45-degree field of view:
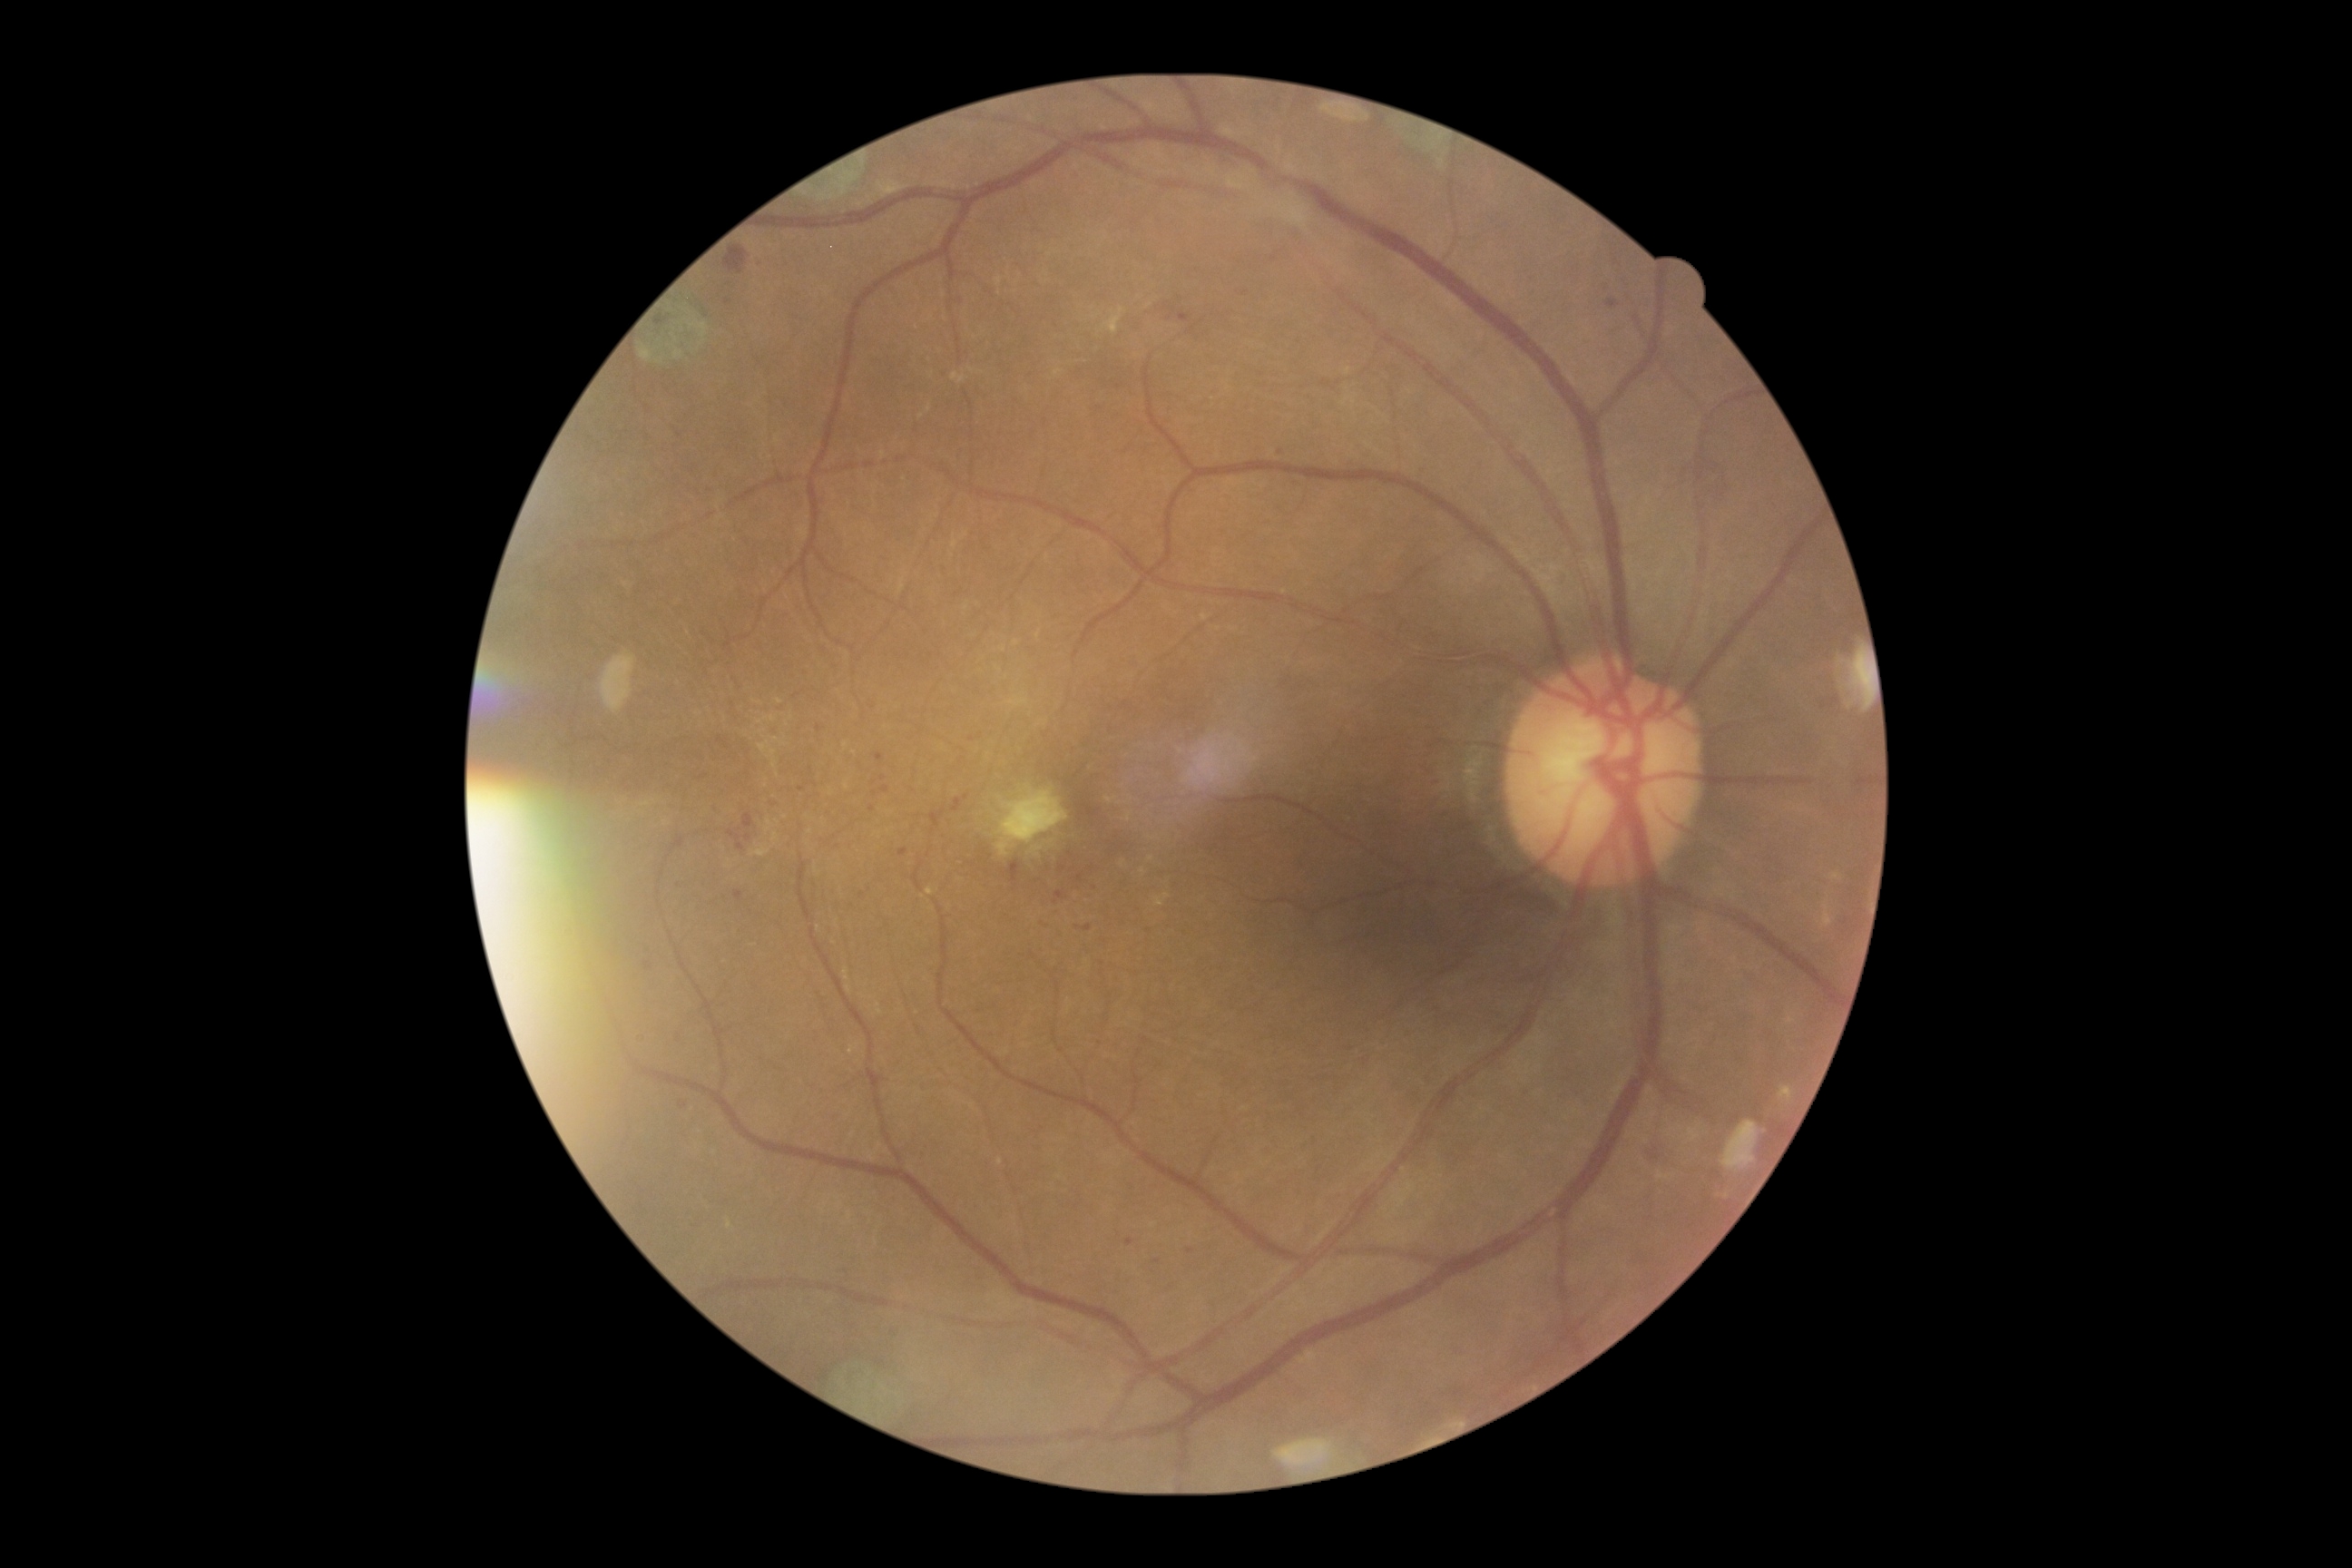

DR stage is 2/4.